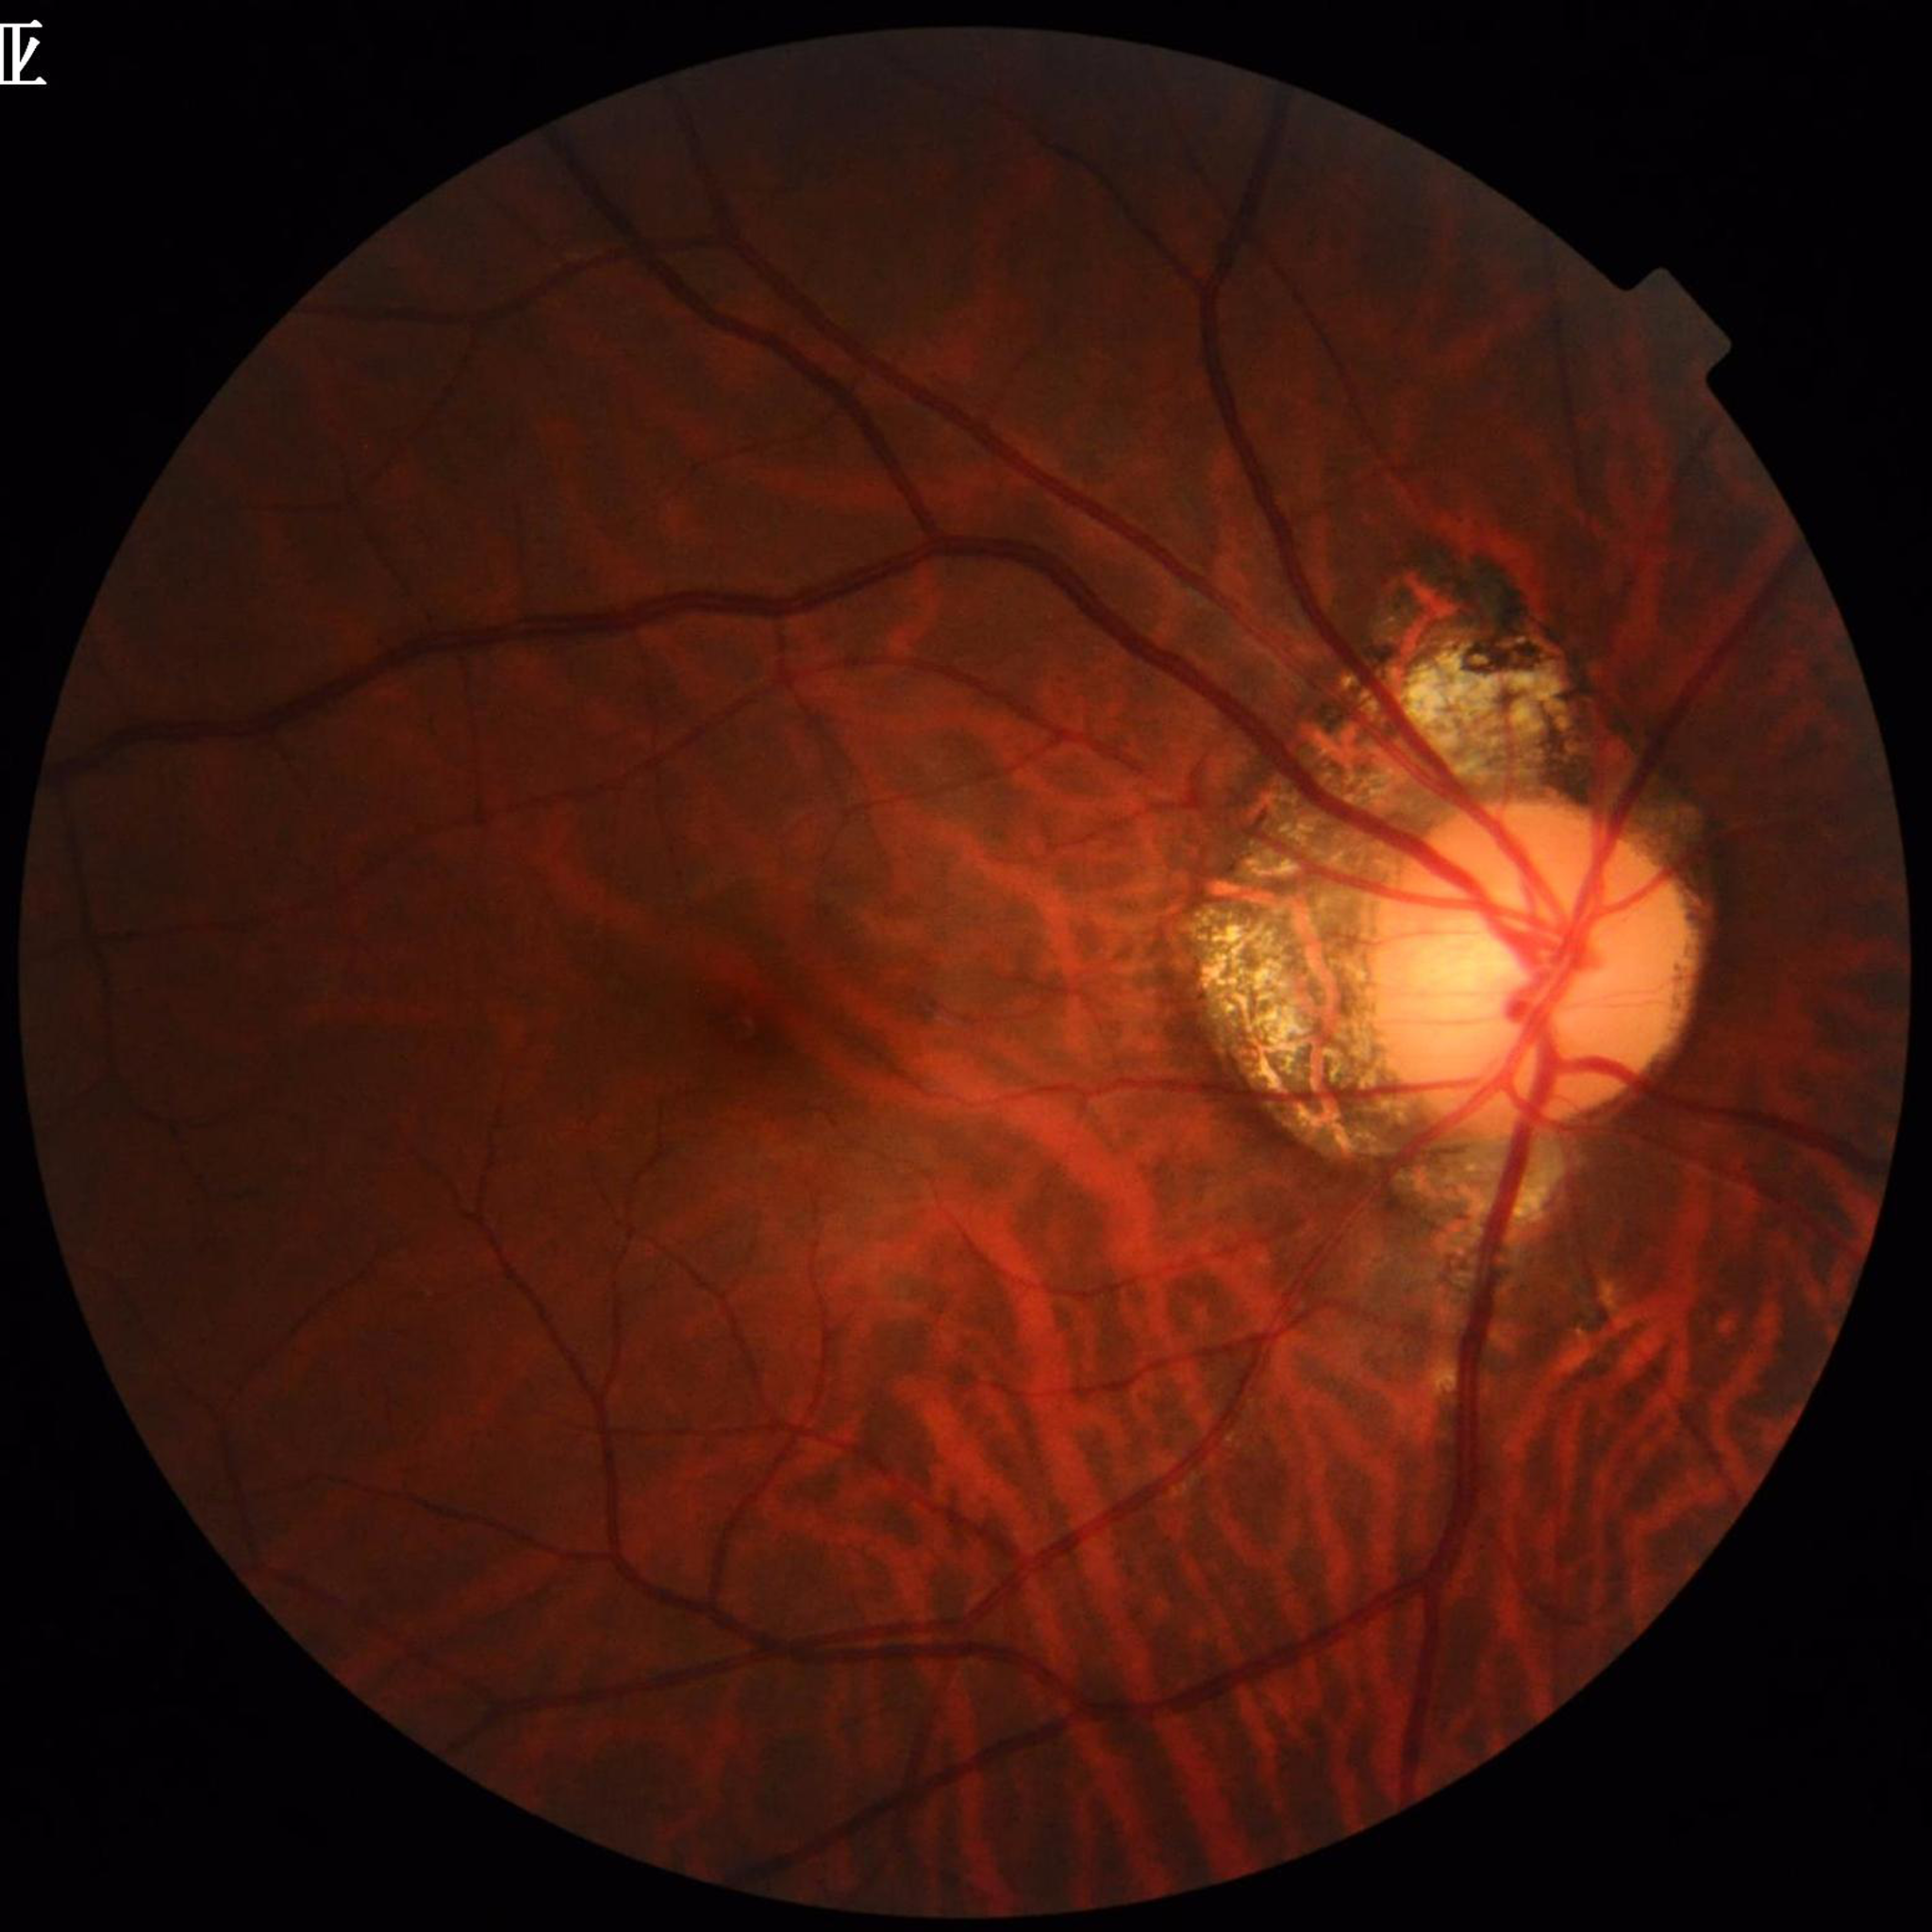

Condition: glaucoma; Photo quality: good.